FOV: 45 degrees · 2048 by 1536 pixels.
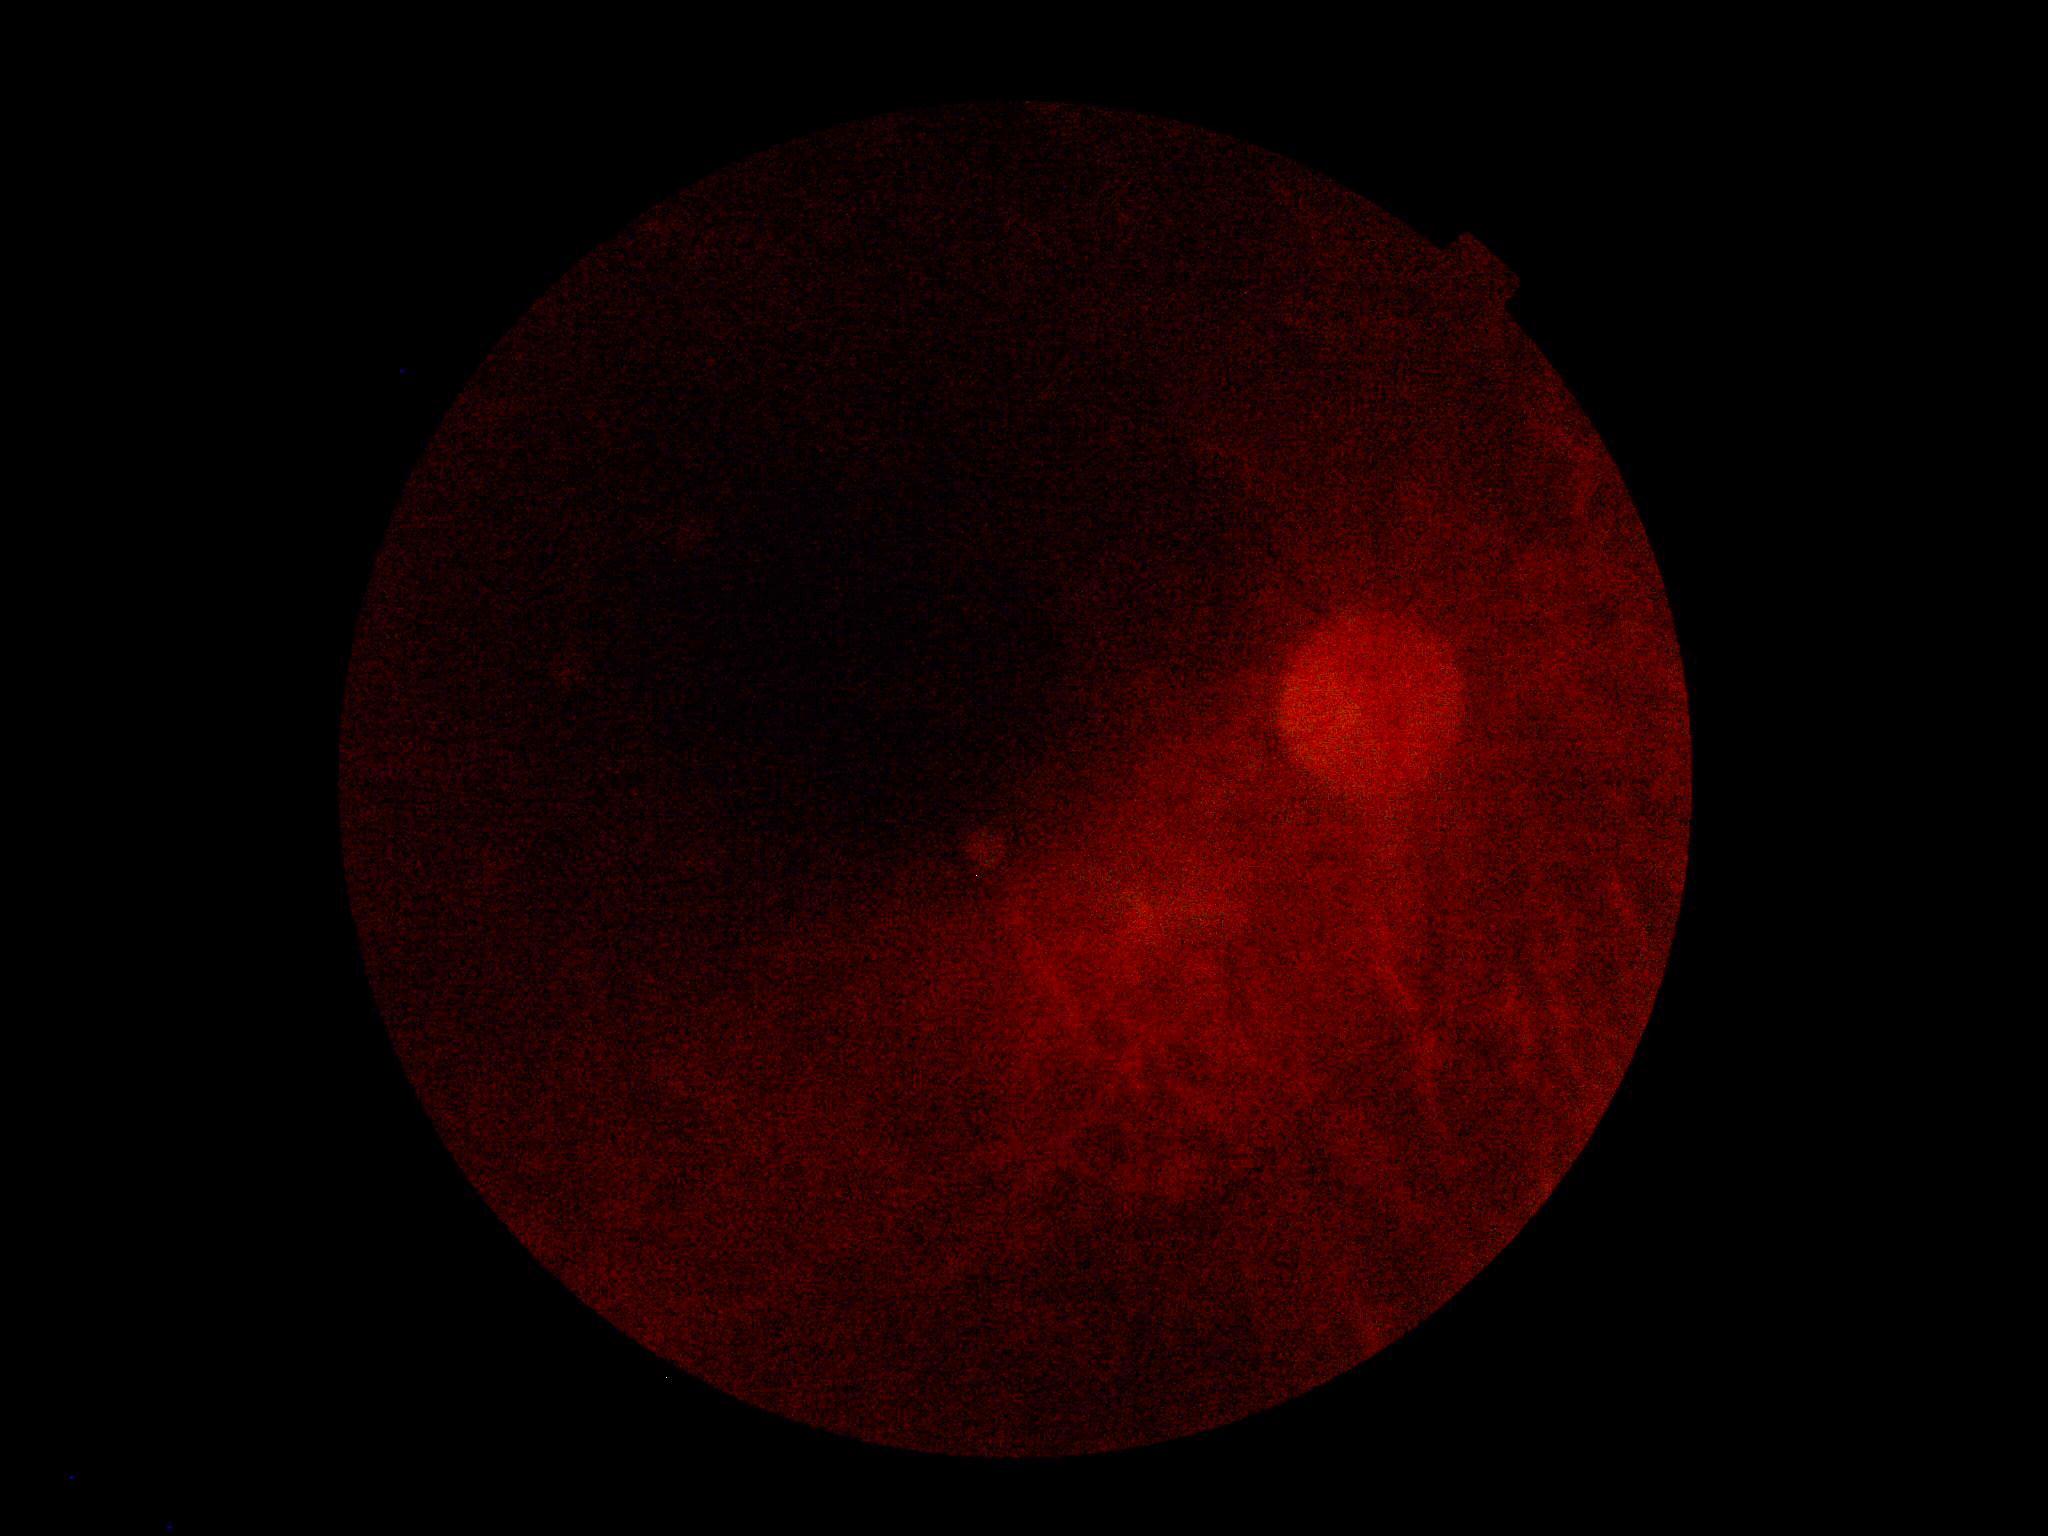
dr_grade: ungradable
quality: too poor for DR grading